2228x1652px, CFP — 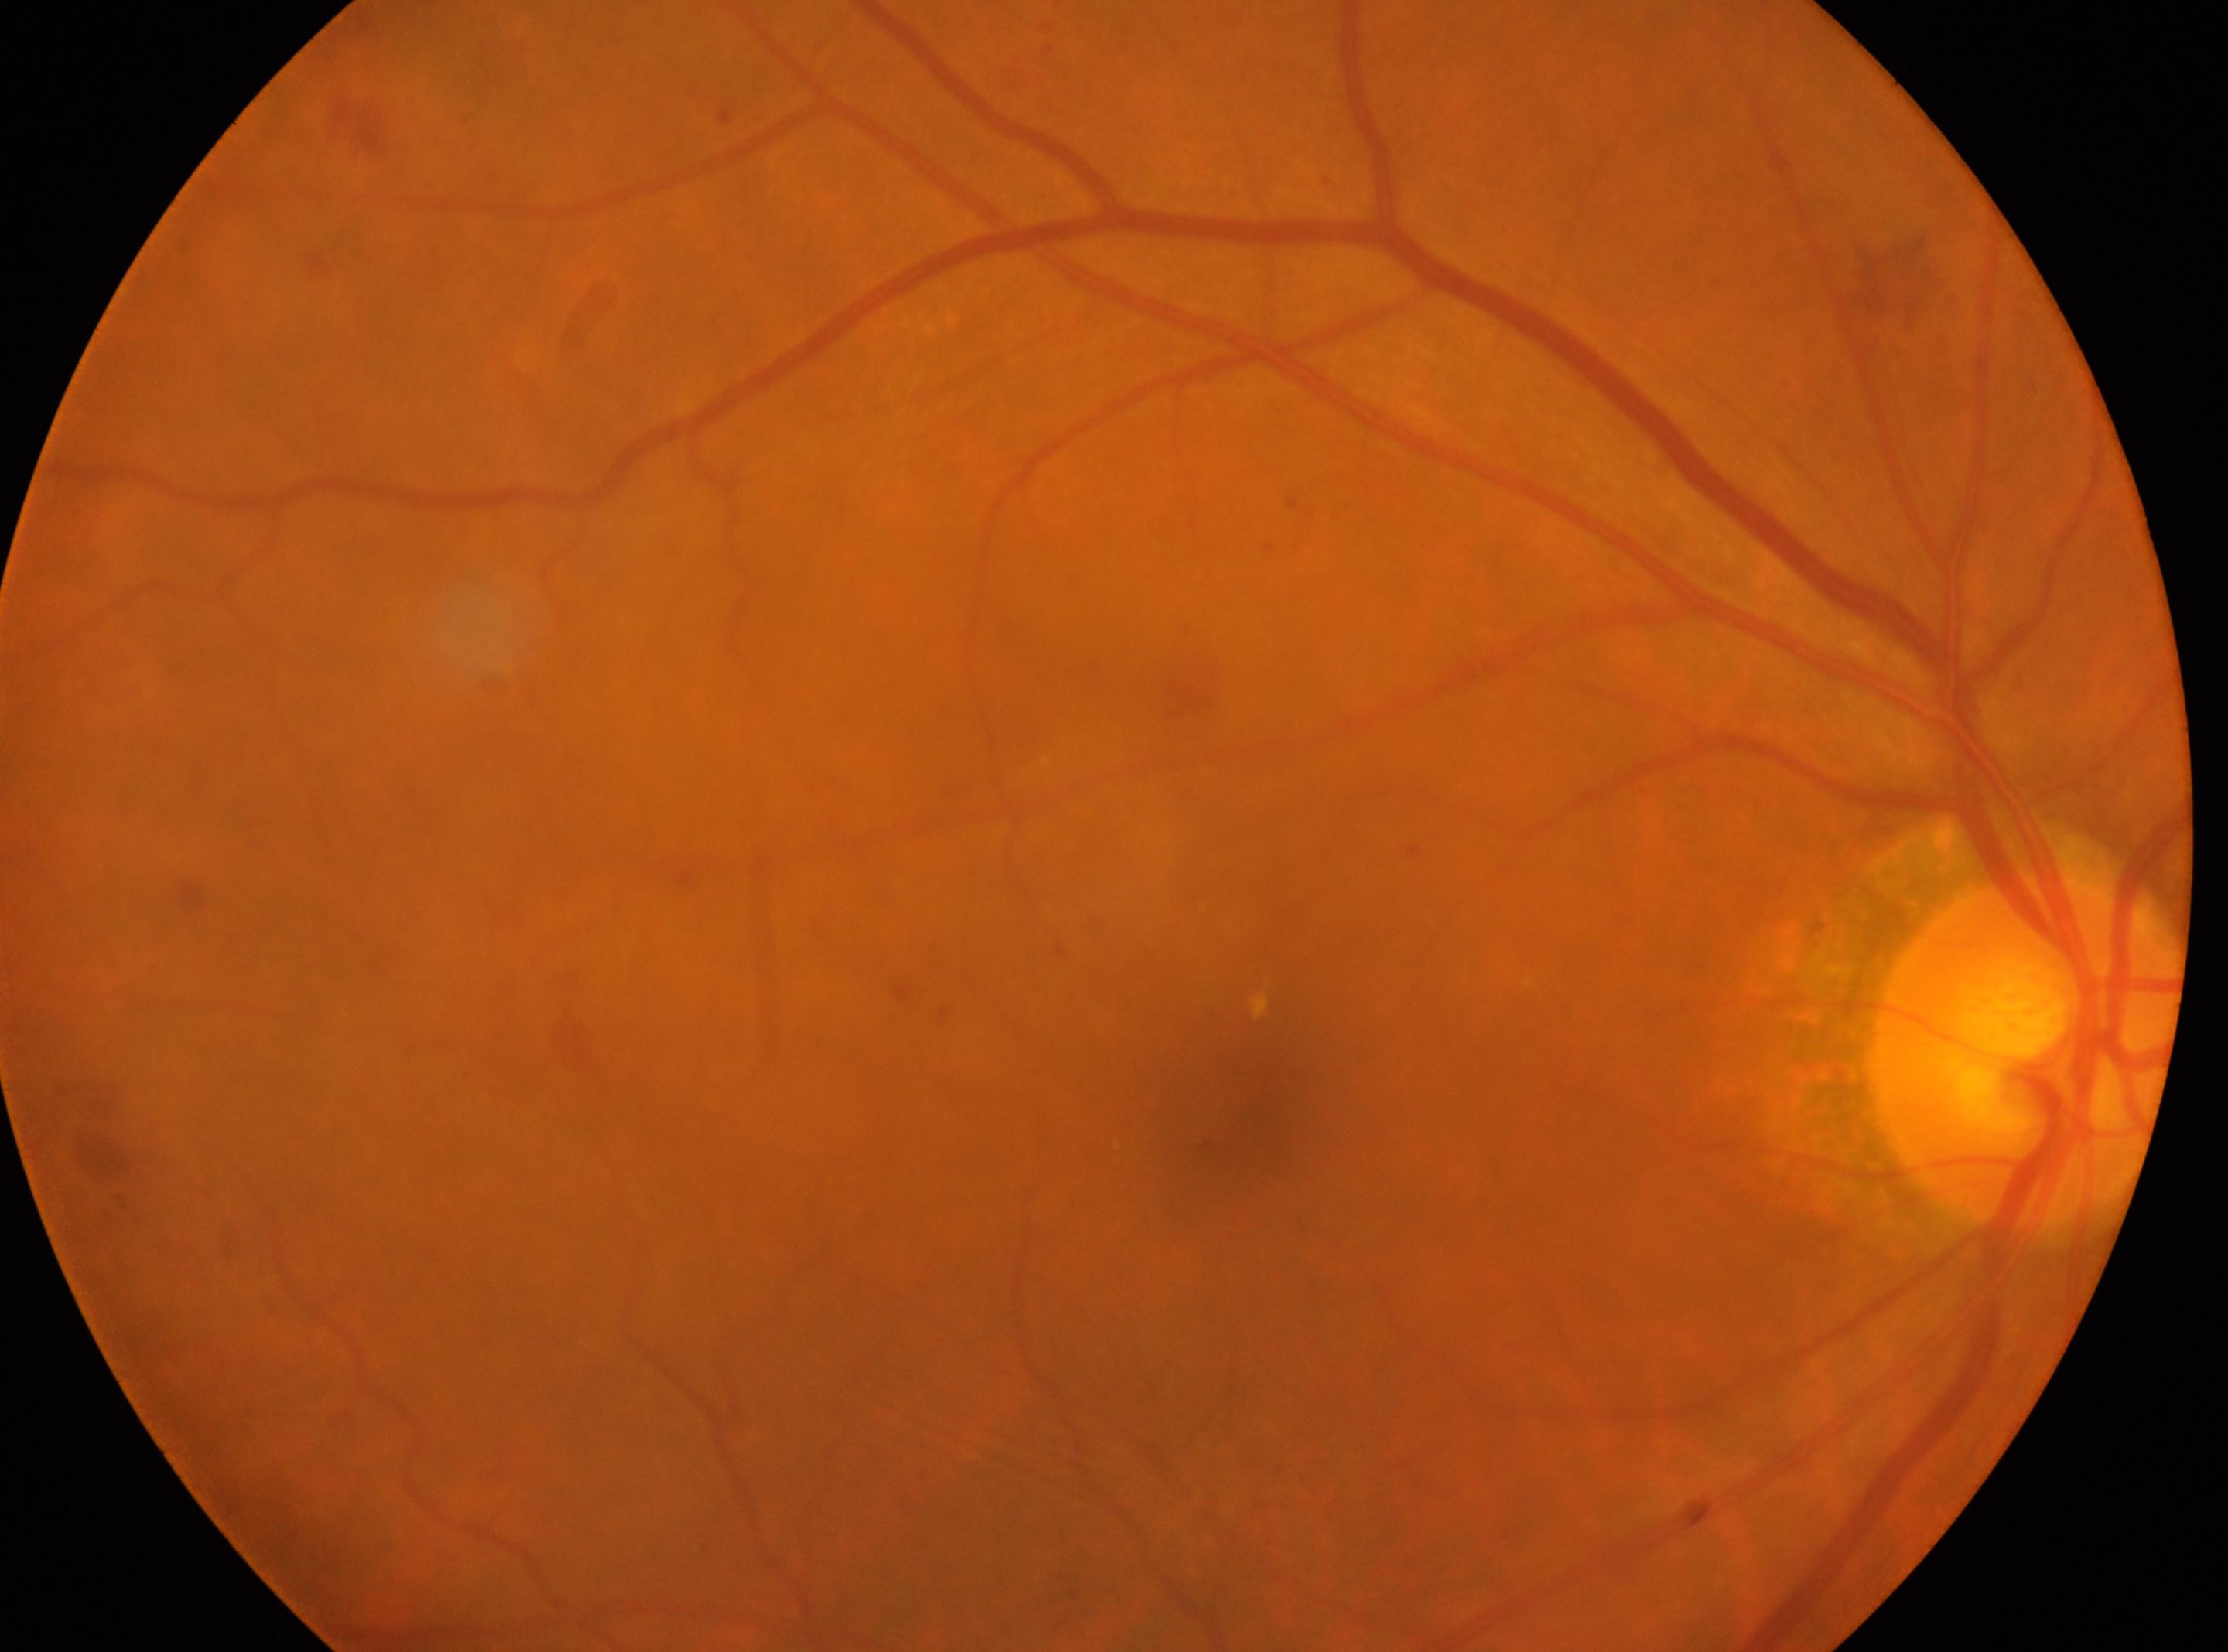
Foveal center: (x=1230, y=1128).
Optic disk located at (x=2029, y=1050).
DR stage: grade 2 (moderate NPDR) — more than just microaneurysms but less than severe NPDR.
This is the oculus dexter.